2352 x 1568 pixels · 45° FOV · fundus photo — 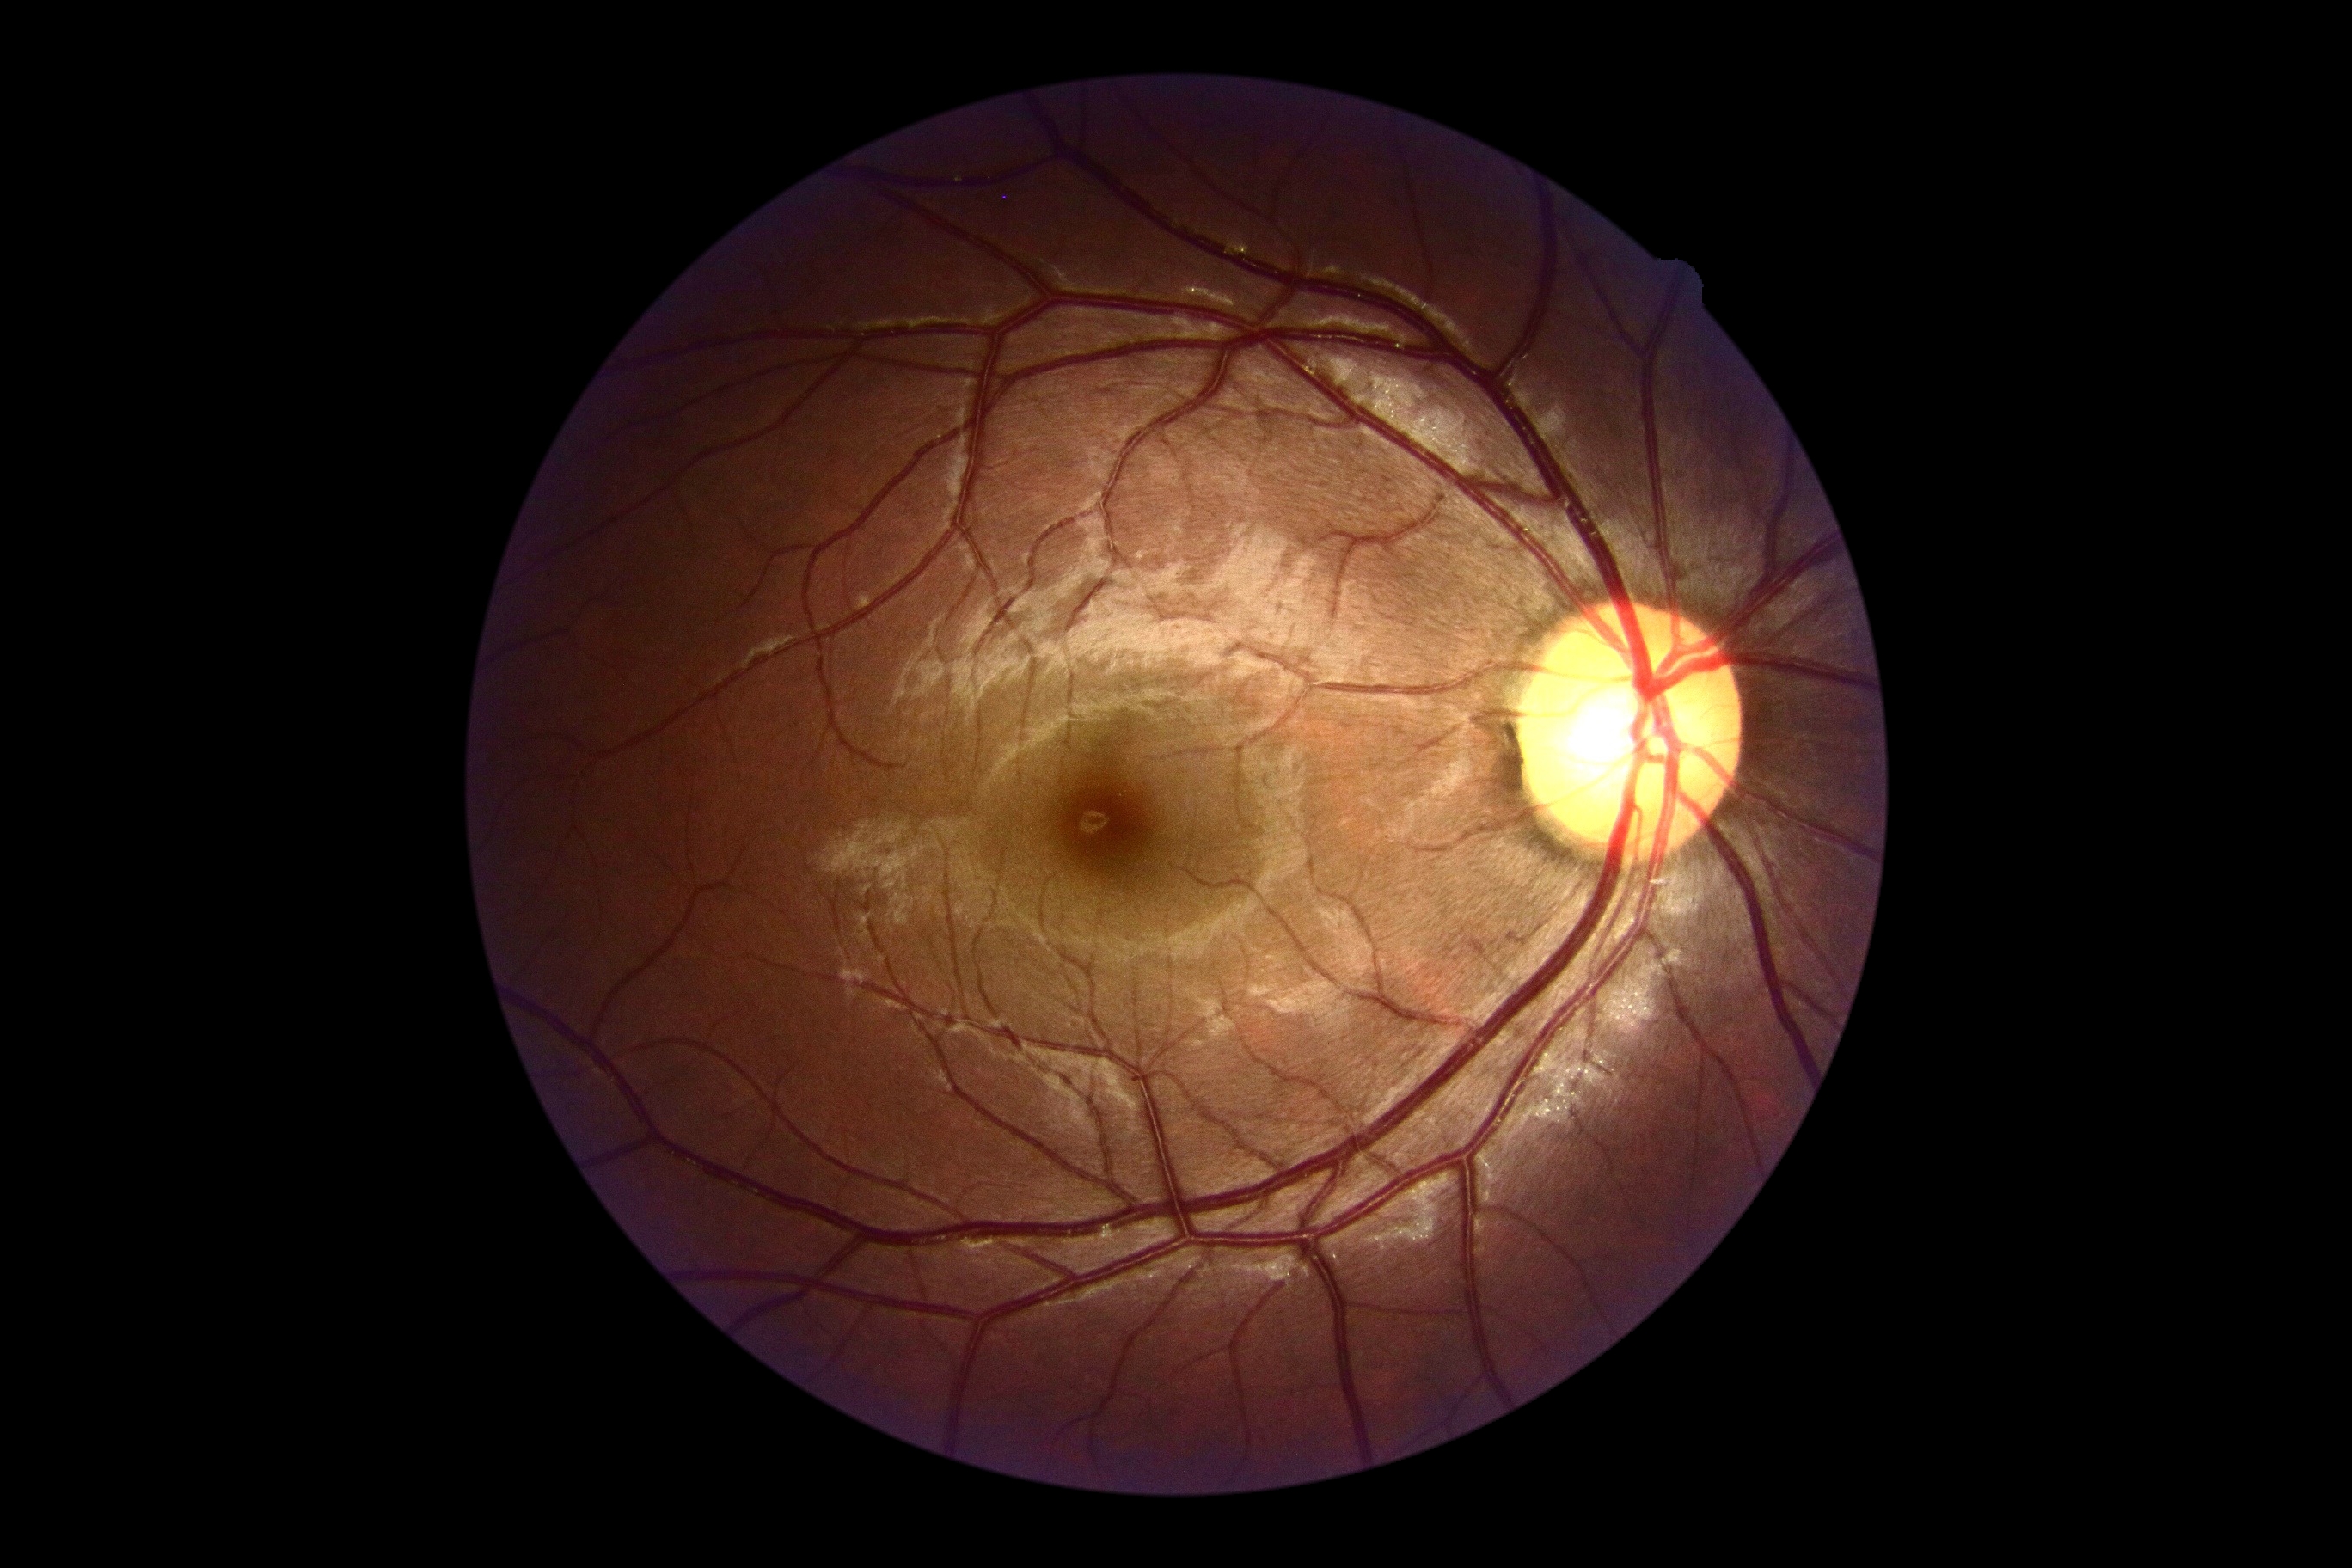 DR impression: no DR findings
DR severity: no apparent retinopathy (grade 0)